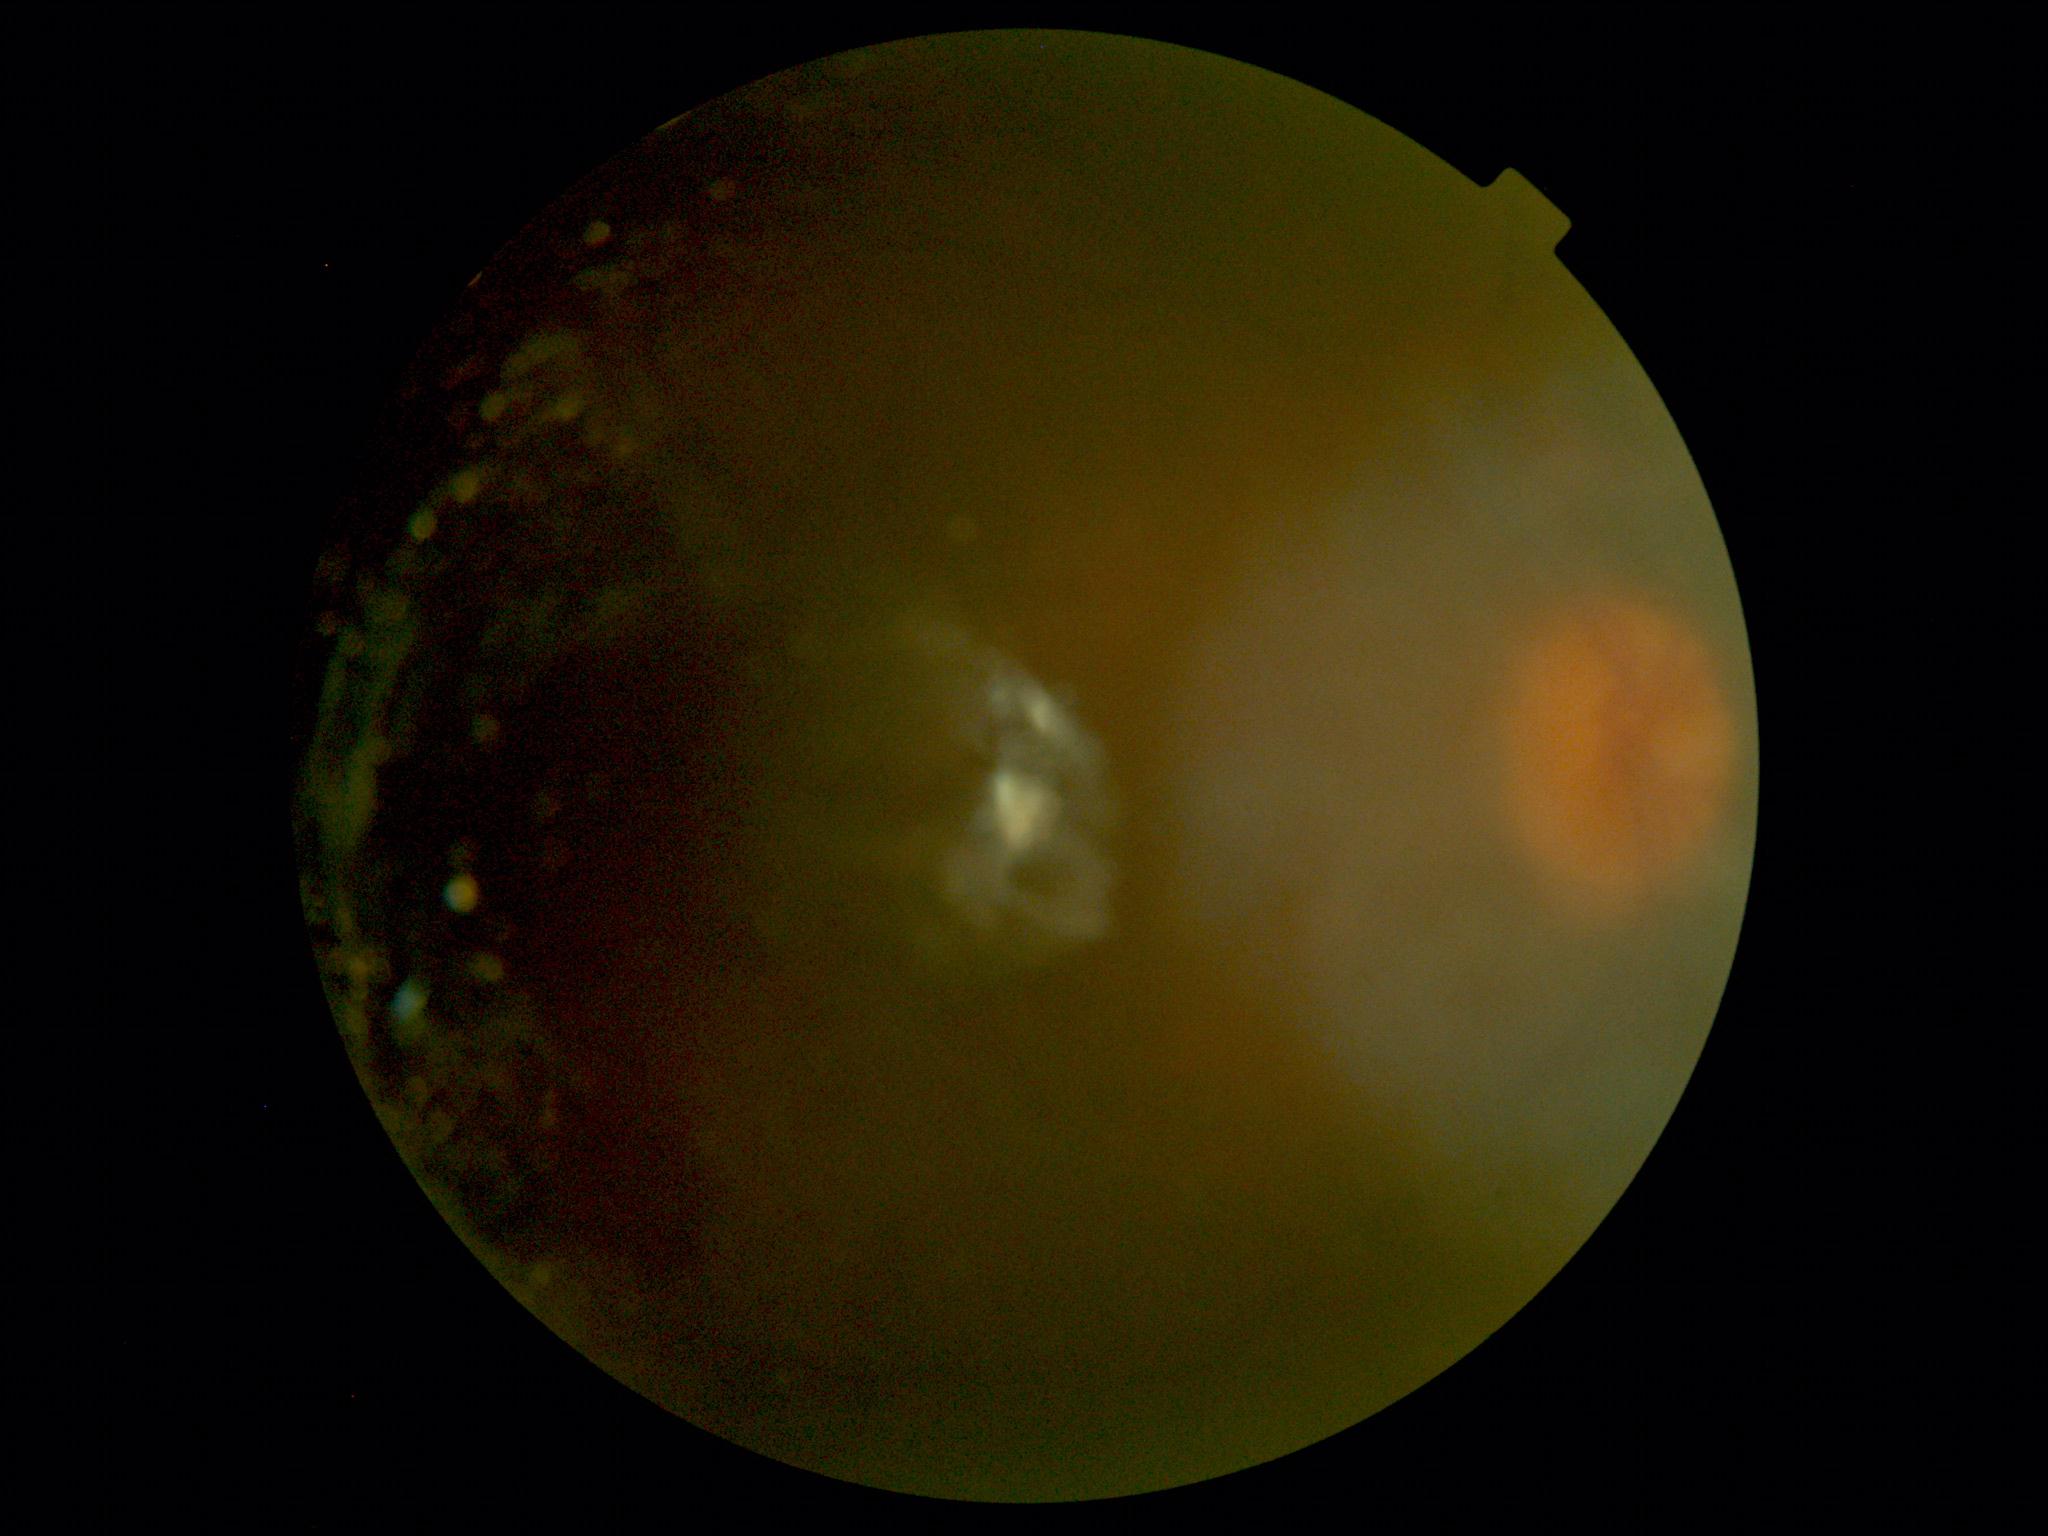
Image quality is insufficient for diabetic retinopathy assessment. Retinopathy grade is ungradable due to poor image quality.